Wide-field fundus image from infant ROP screening; 100° field of view (Phoenix ICON); 1240 x 1240 pixels:
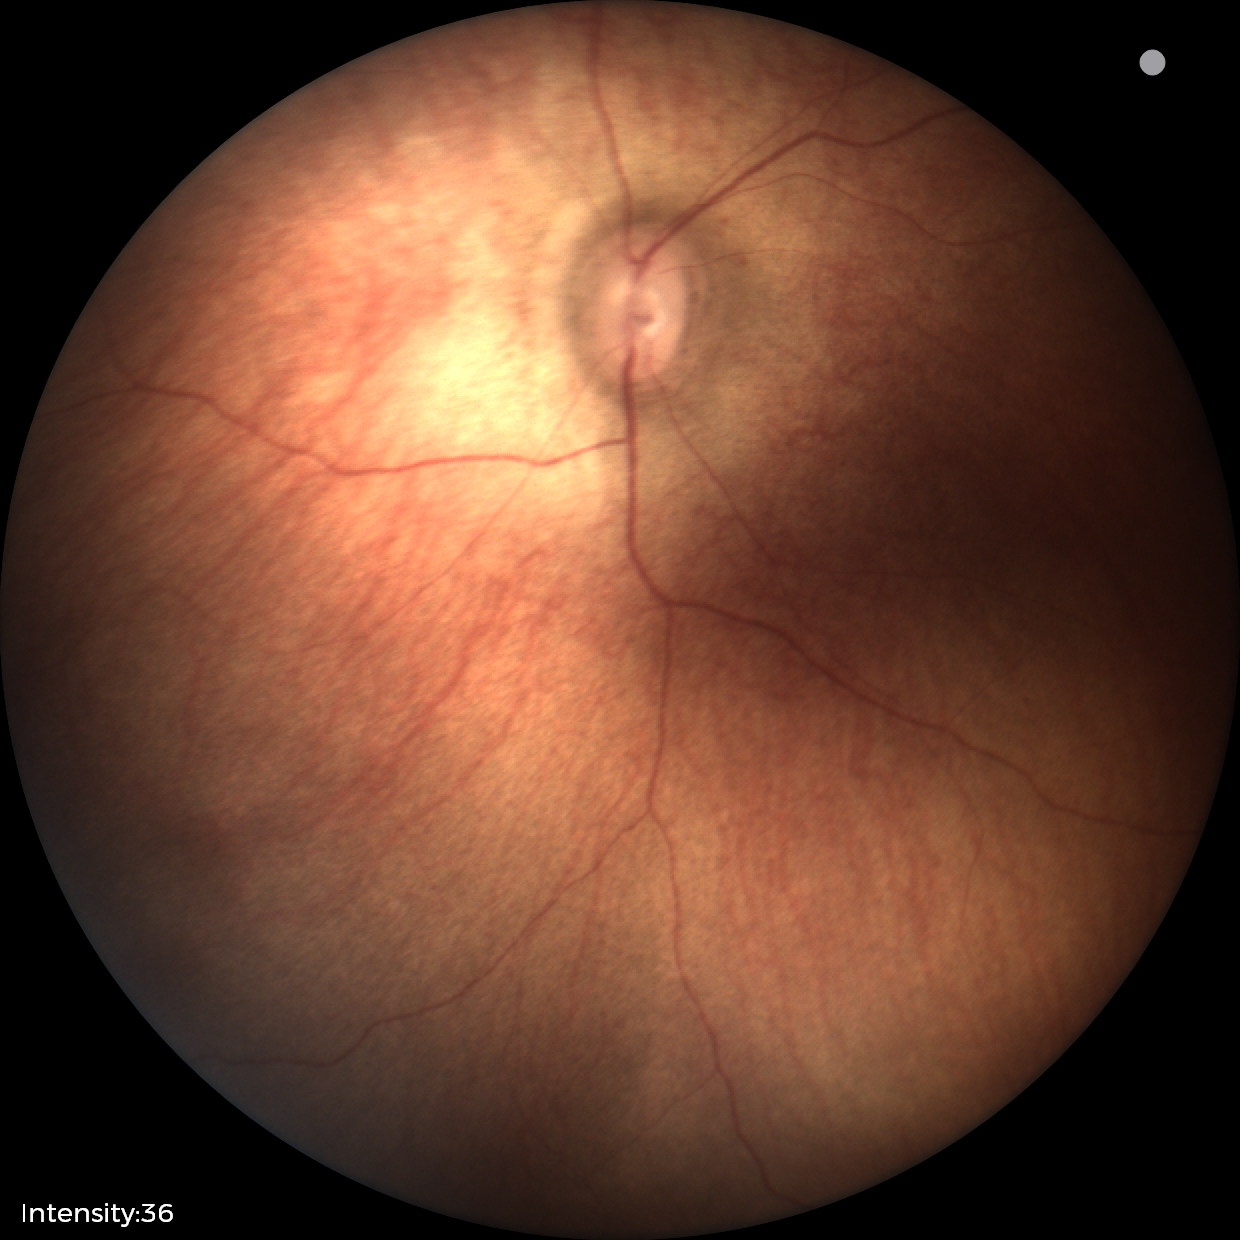

Examination with physiological retinal findings.